Infant wide-field fundus photograph — 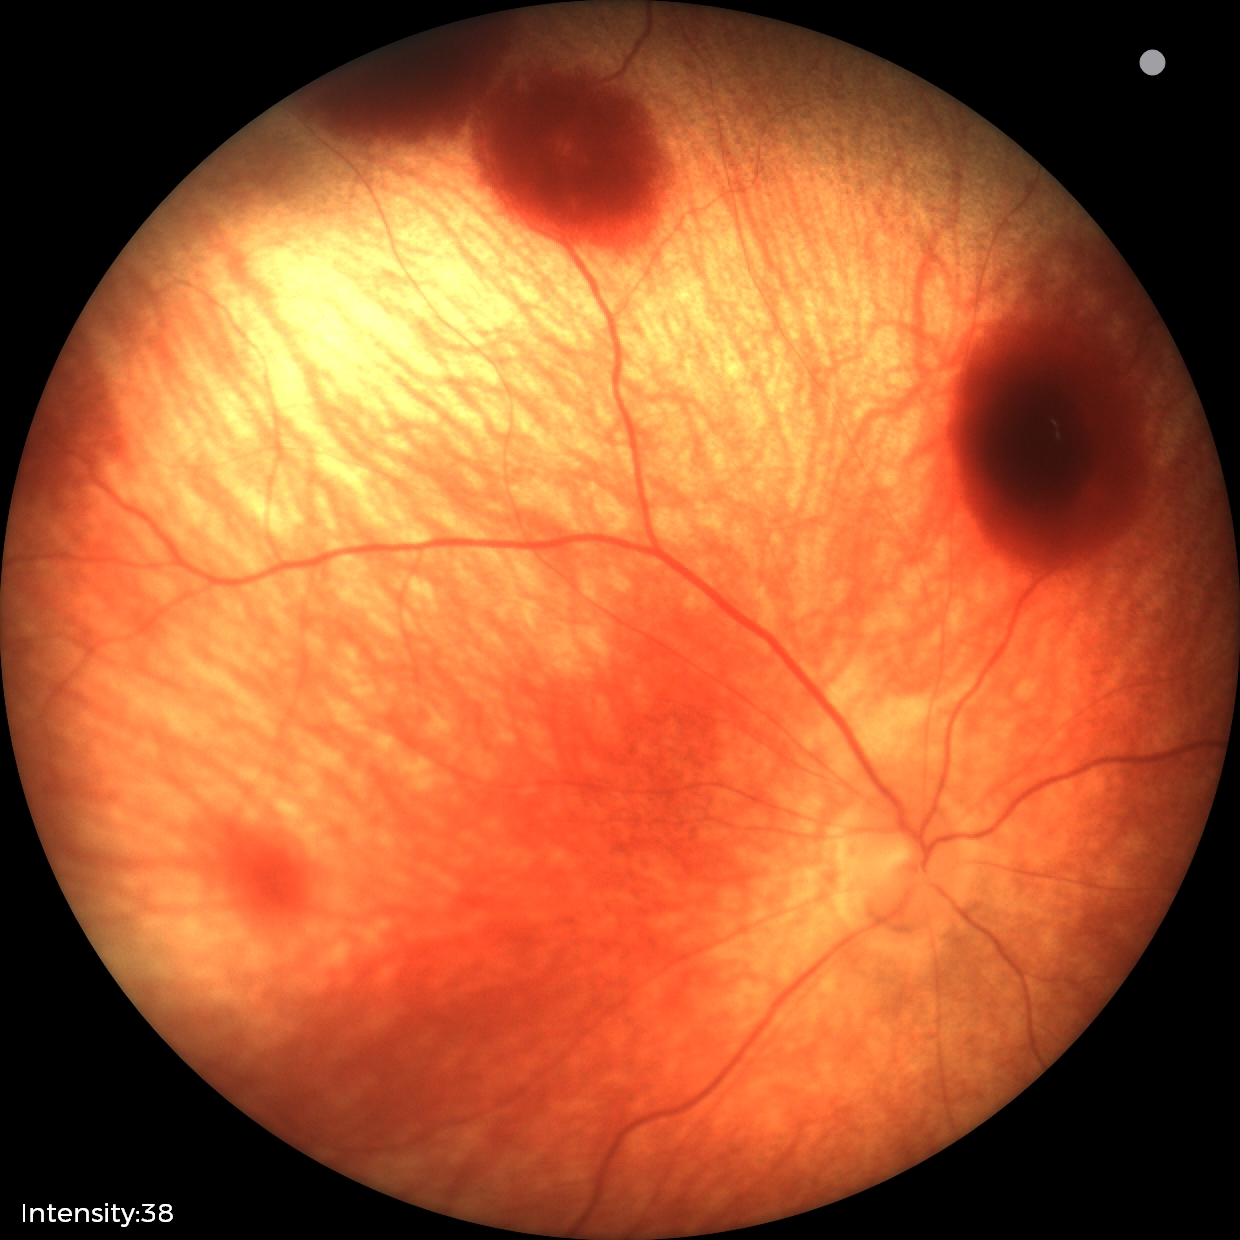
From an examination with diagnosis of retinal hemorrhages.